Wide-field fundus photograph of an infant
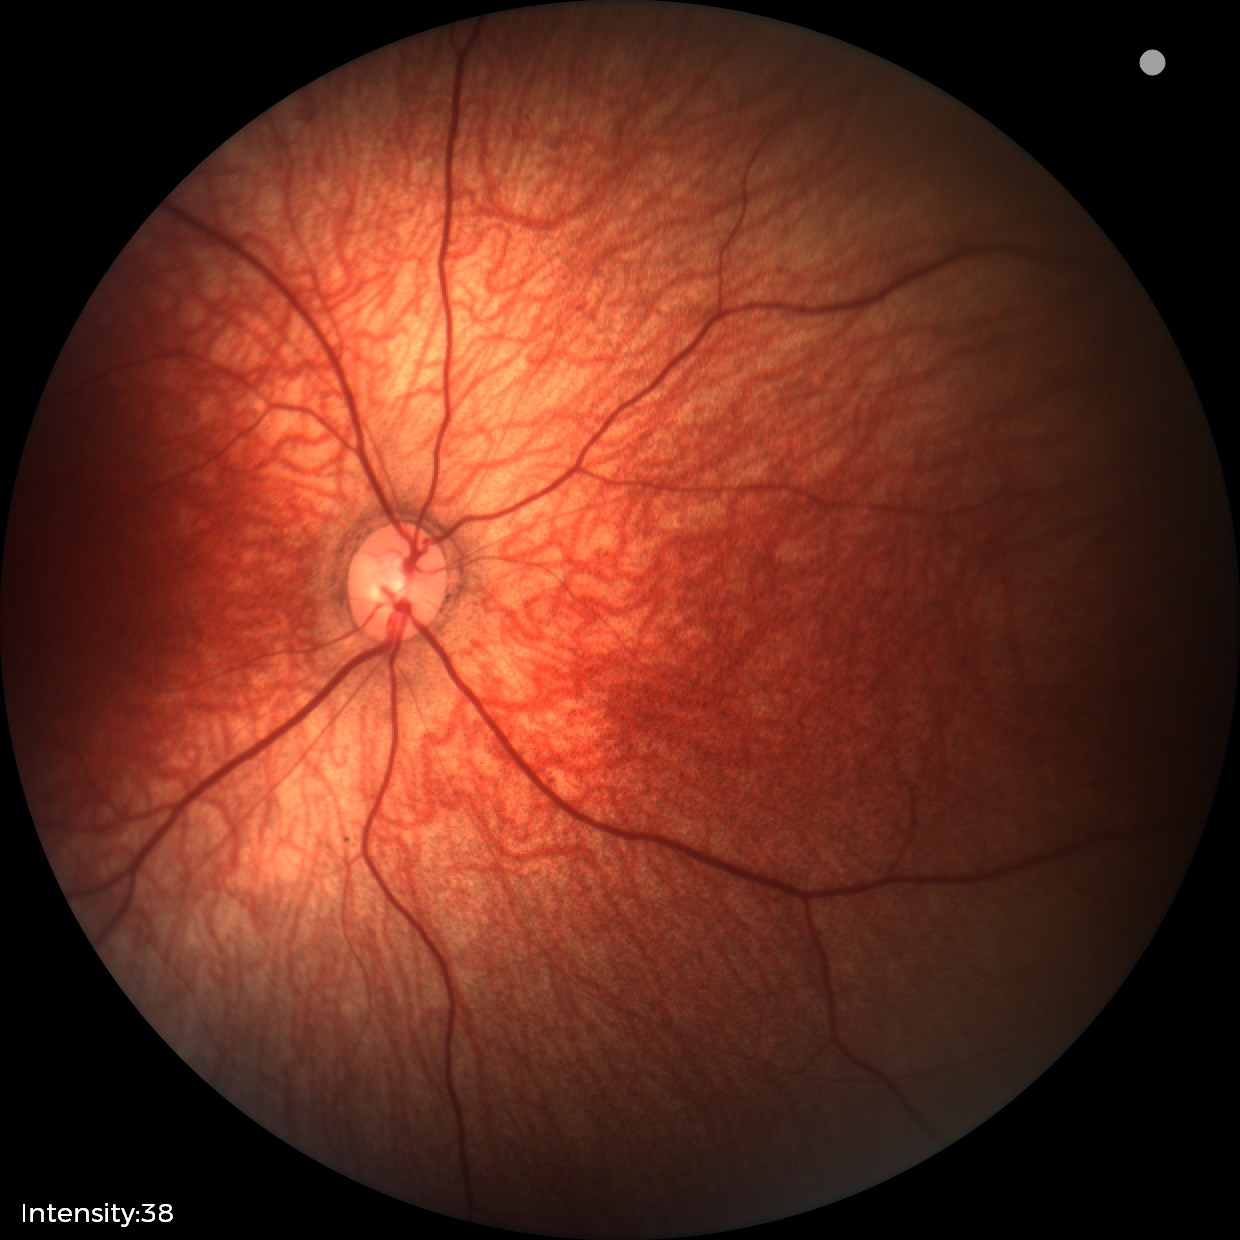
Physiological retinal appearance for postconceptual age.